NIDEK AFC-230; 45° field of view; nonmydriatic: 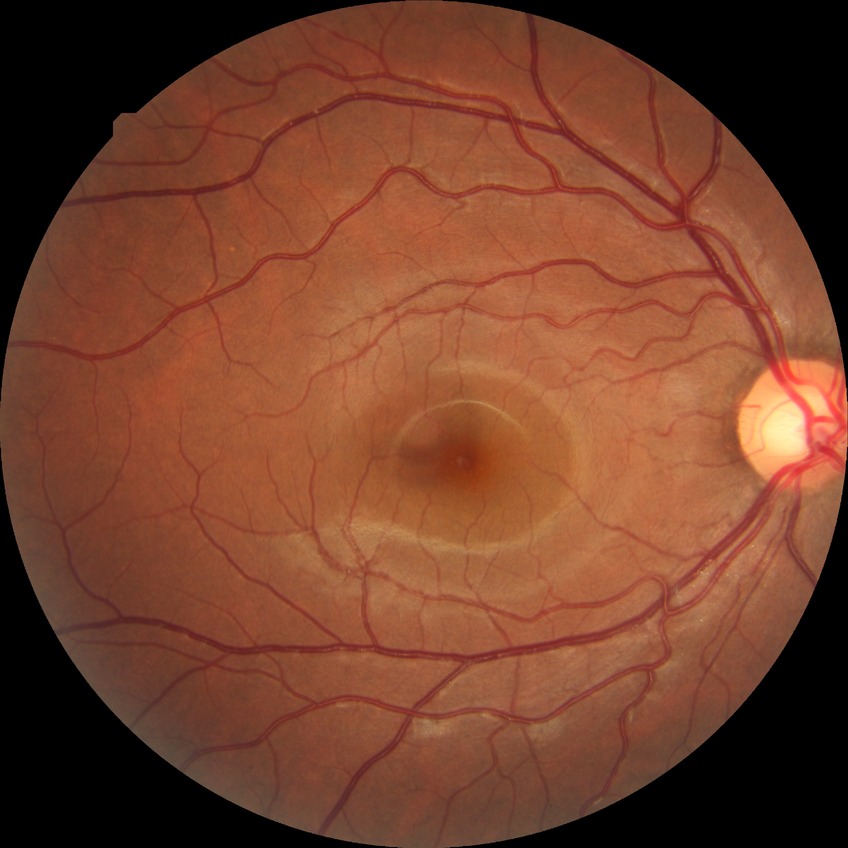 Diabetic retinopathy severity: no diabetic retinopathy.